Color fundus photograph
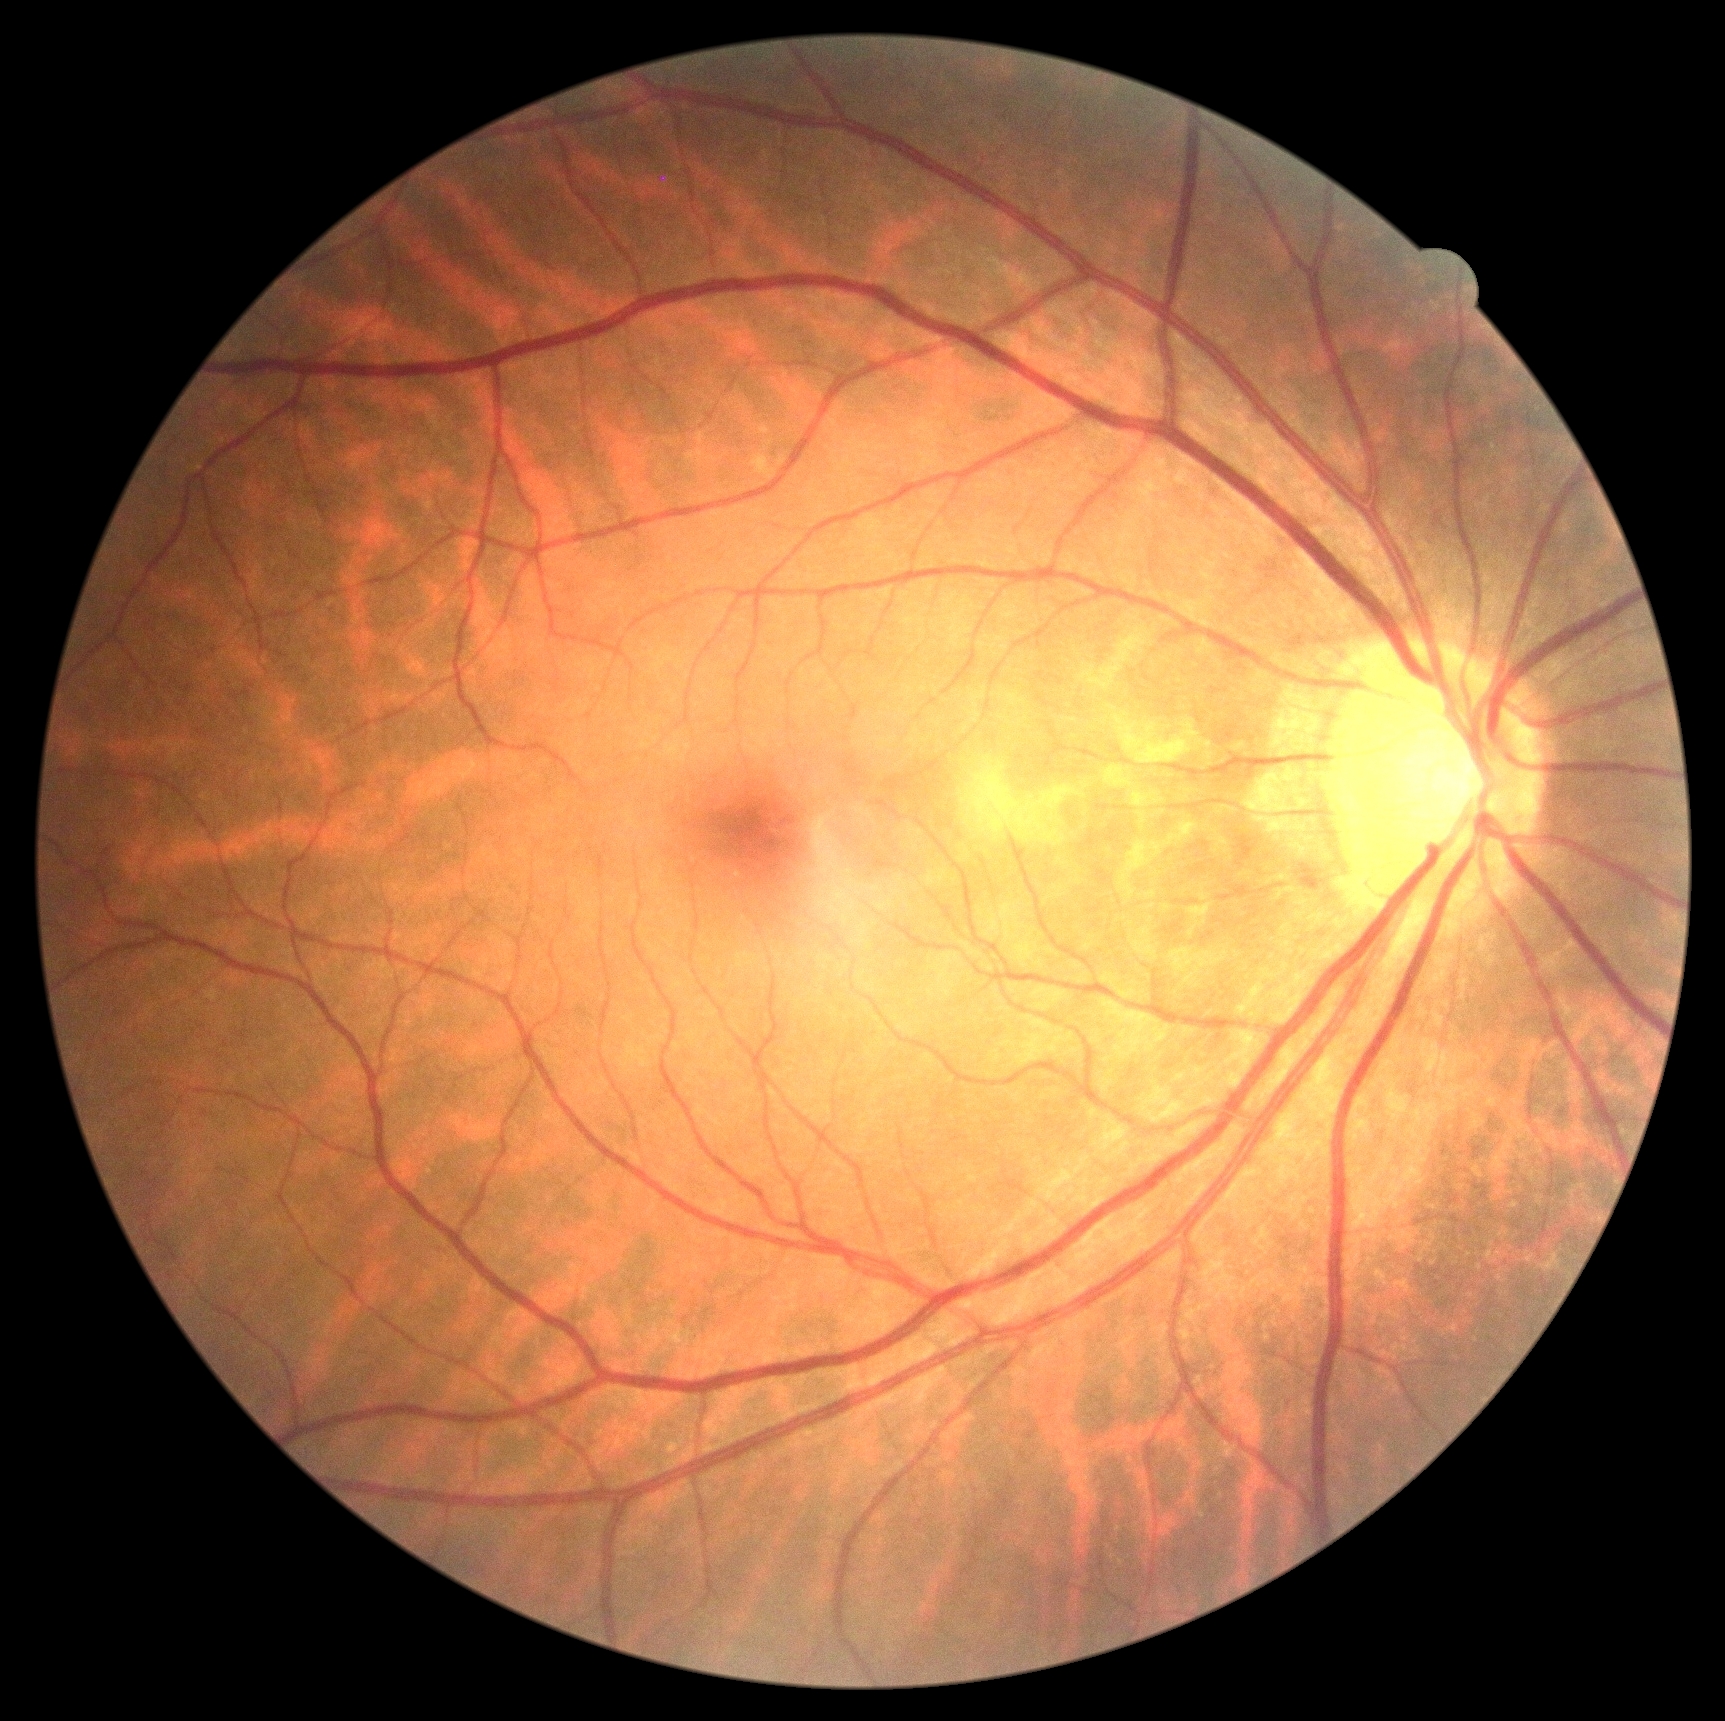 DR: no apparent retinopathy (grade 0).